Acquired with a NIDEK AFC-230, modified Davis classification
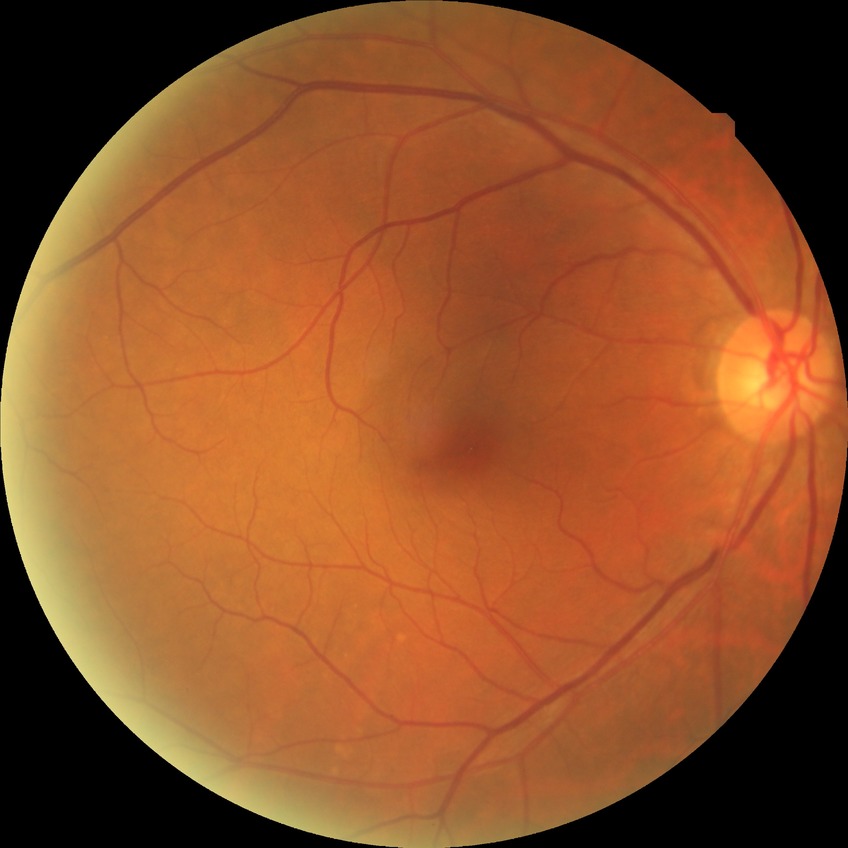

diabetic retinopathy (DR): NDR (no diabetic retinopathy)